Color fundus image — 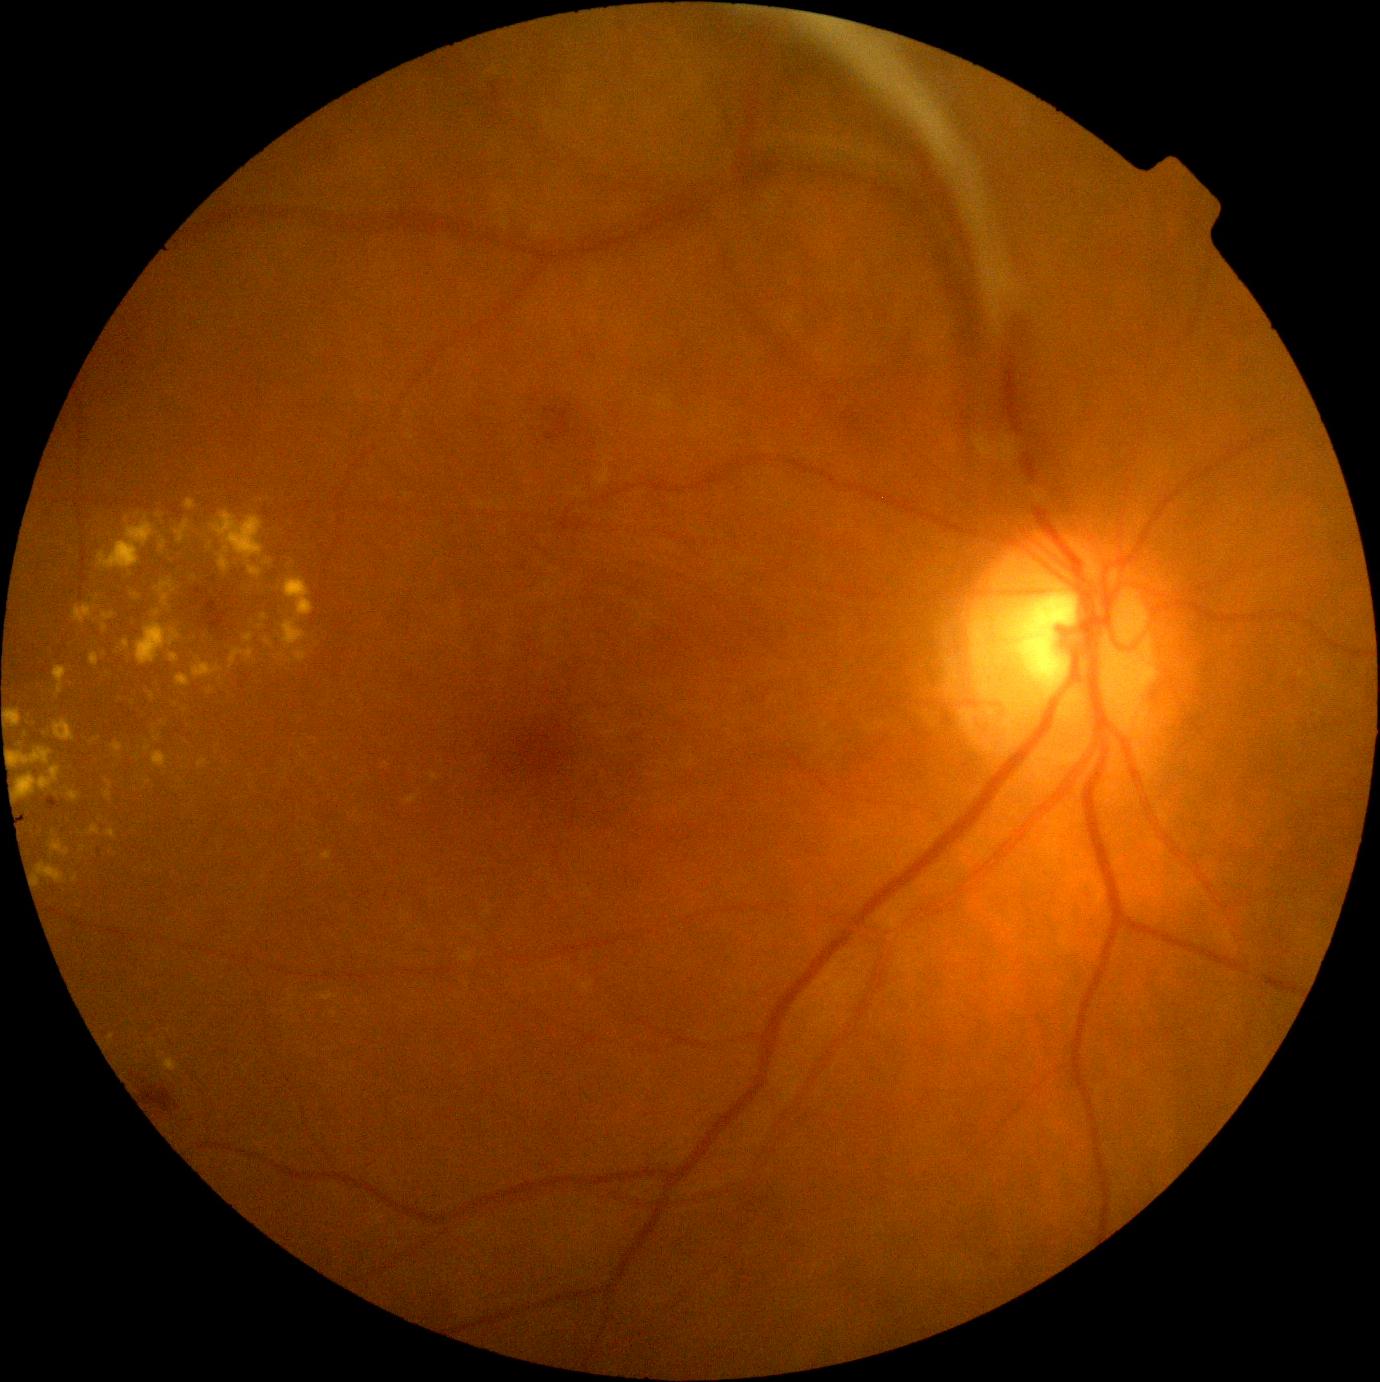

DR severity: PDR (grade 4).